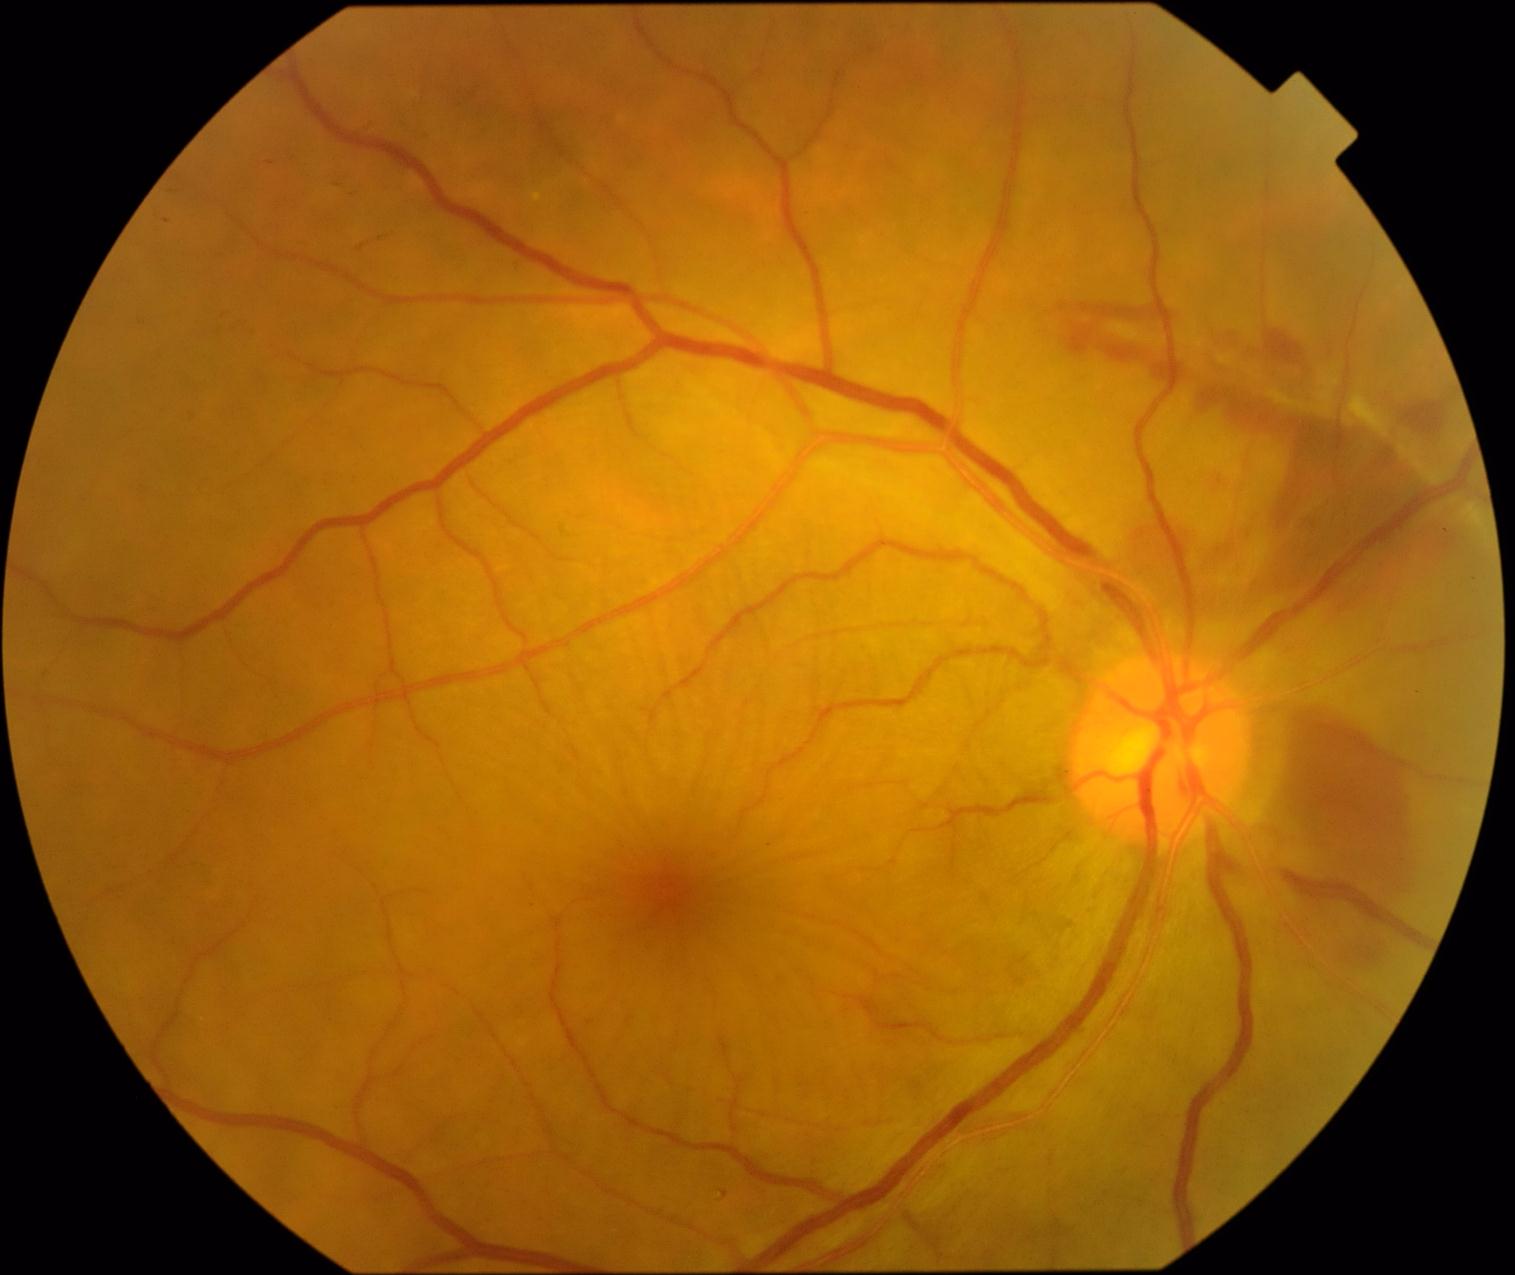
Diabetic retinopathy (DR): PDR (grade 4).